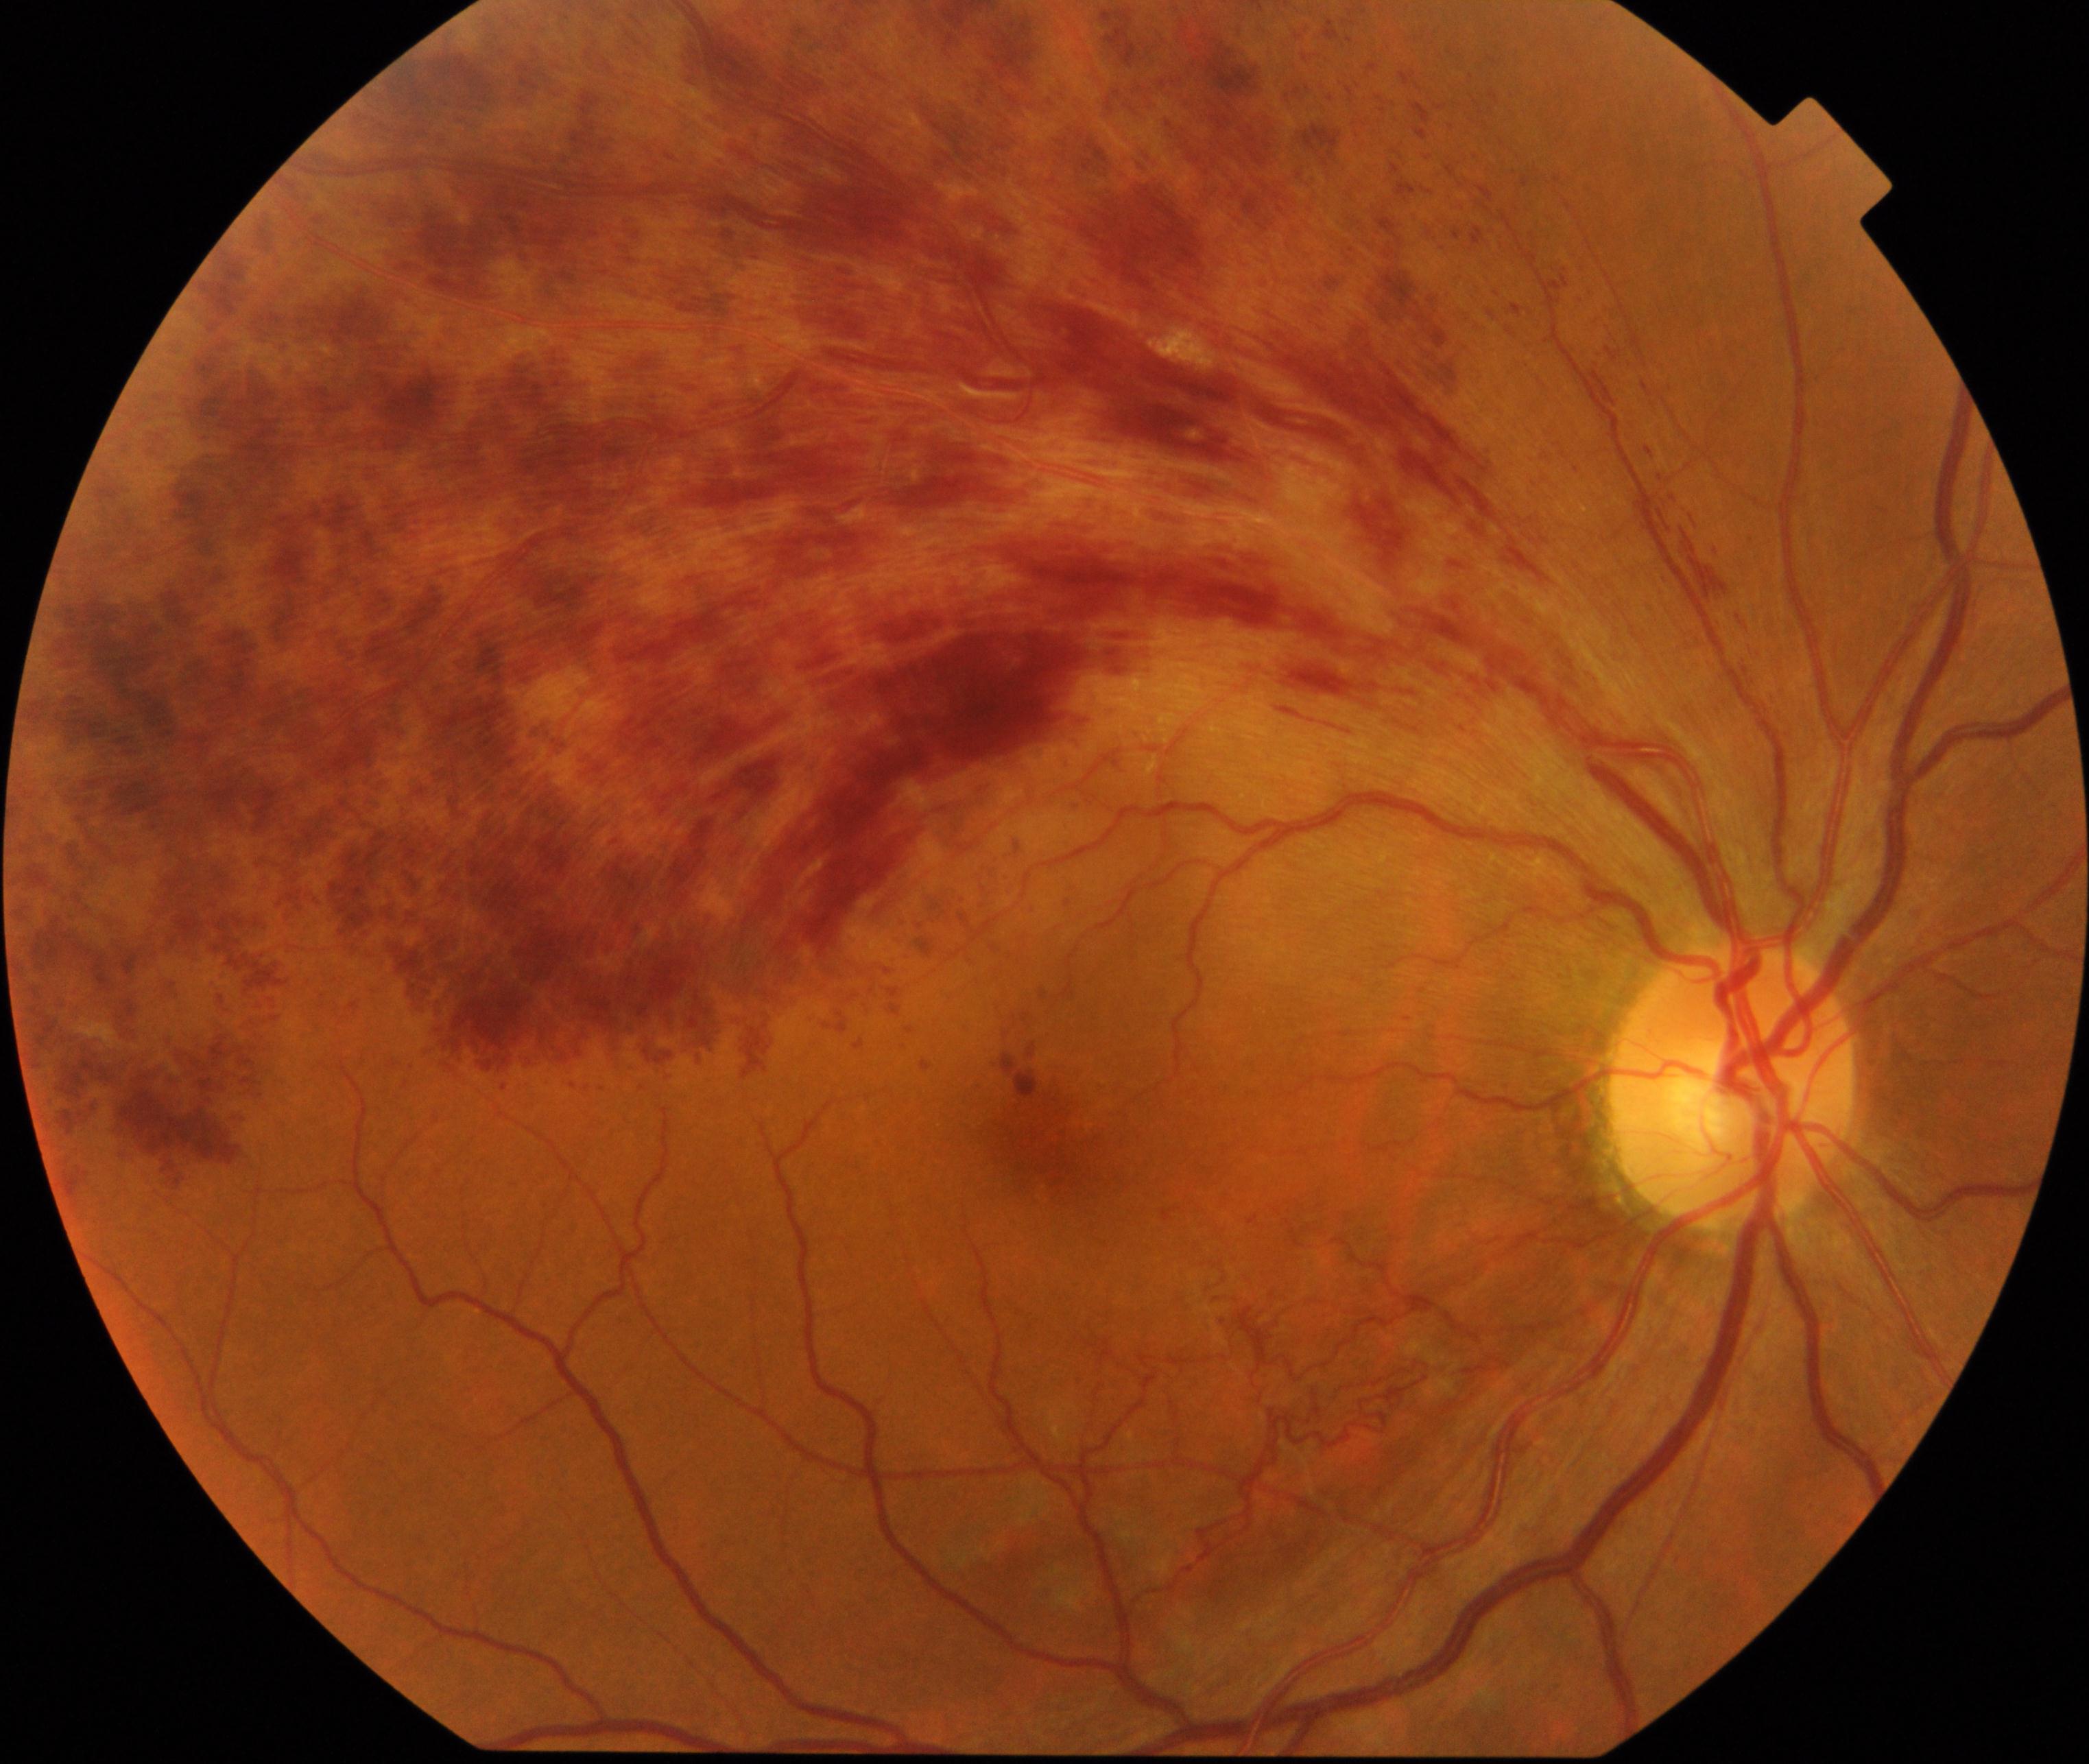

Diagnosis: branch retinal vein occlusion. Typically showing tortuosity and dilatation of affected veins, with dot, blot, and flame hemorrhages, sometimes with cotton-wool spots or hard exudates.